Nonmydriatic: 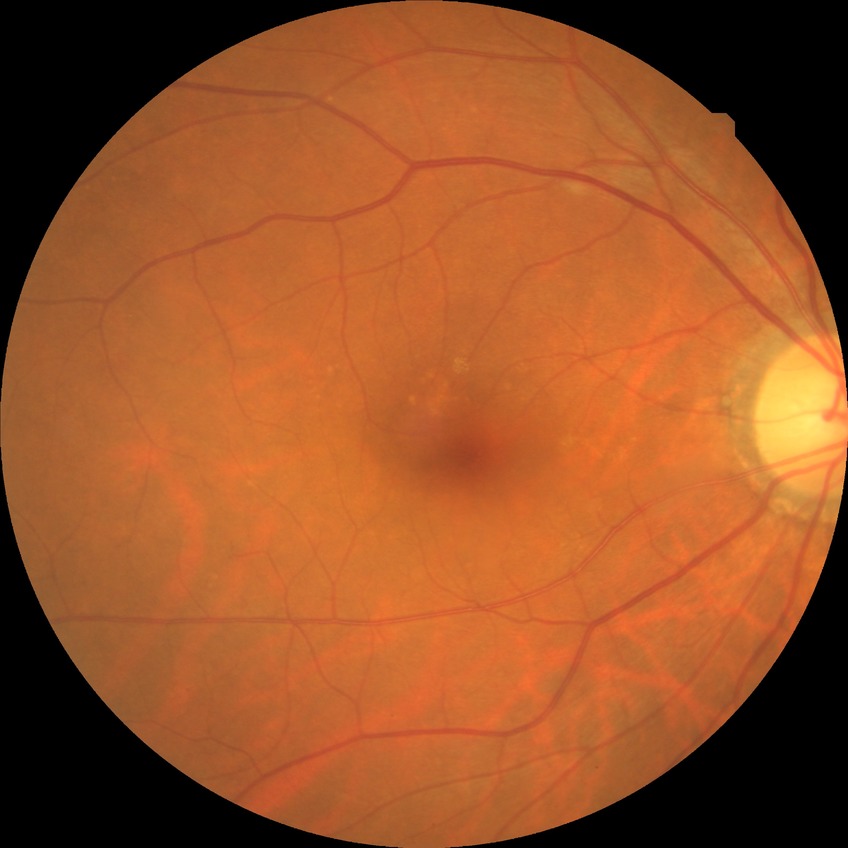
diabetic retinopathy (DR) = NDR (no diabetic retinopathy)